1240 by 1240 pixels. Pediatric wide-field fundus photograph: 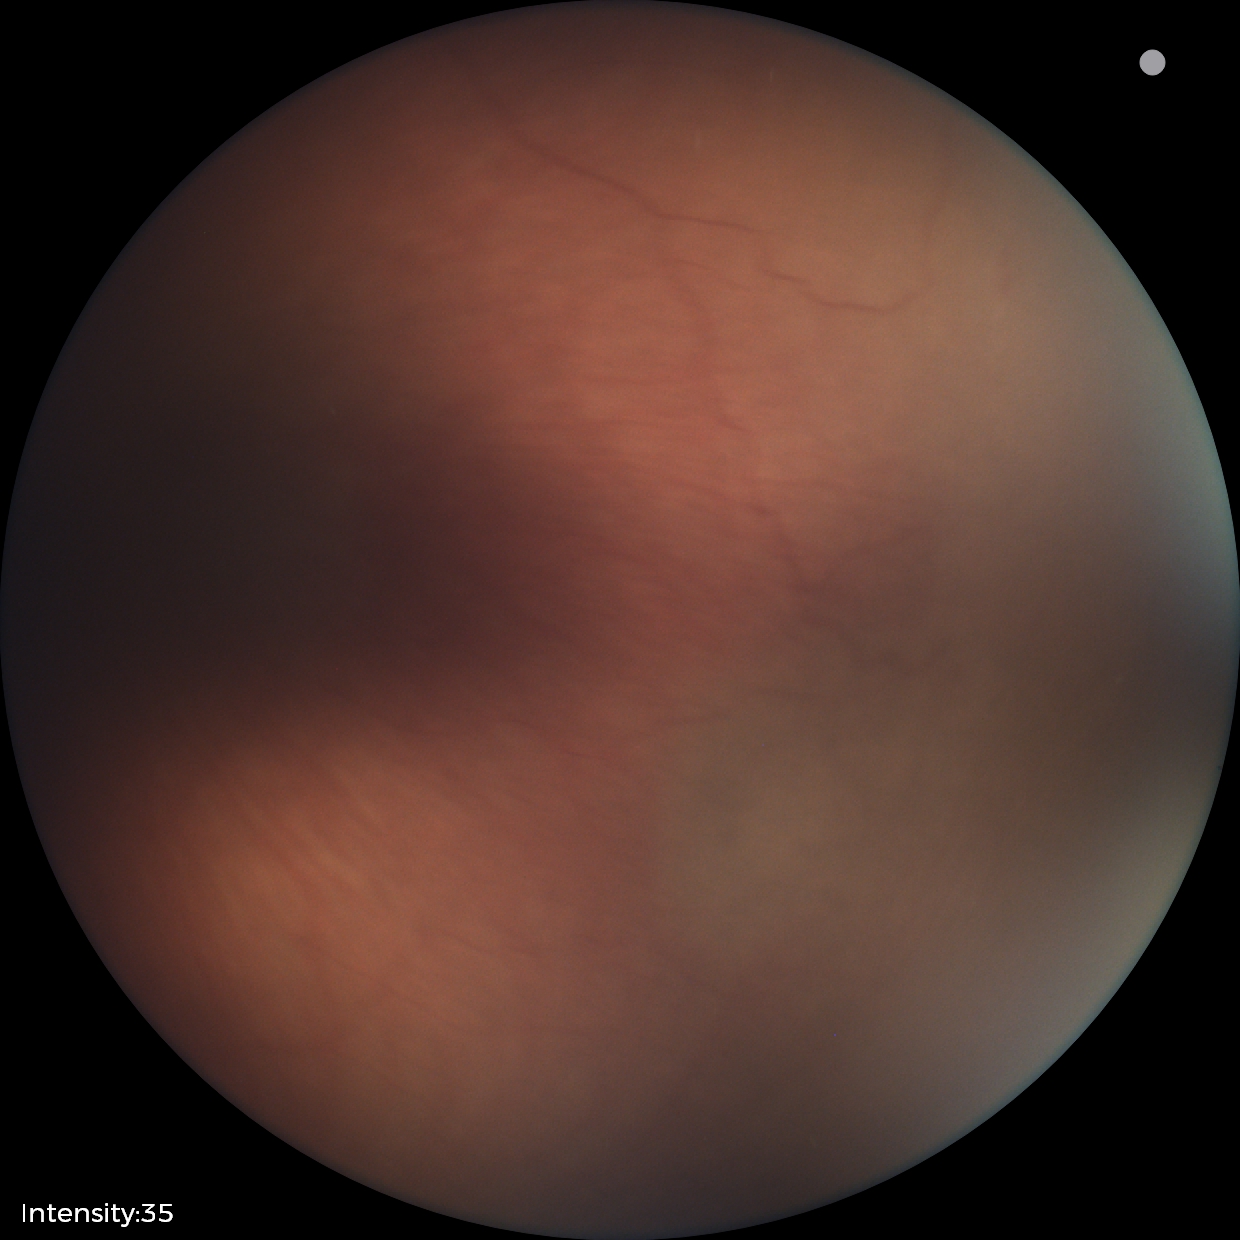 Examination with physiological retinal findings.